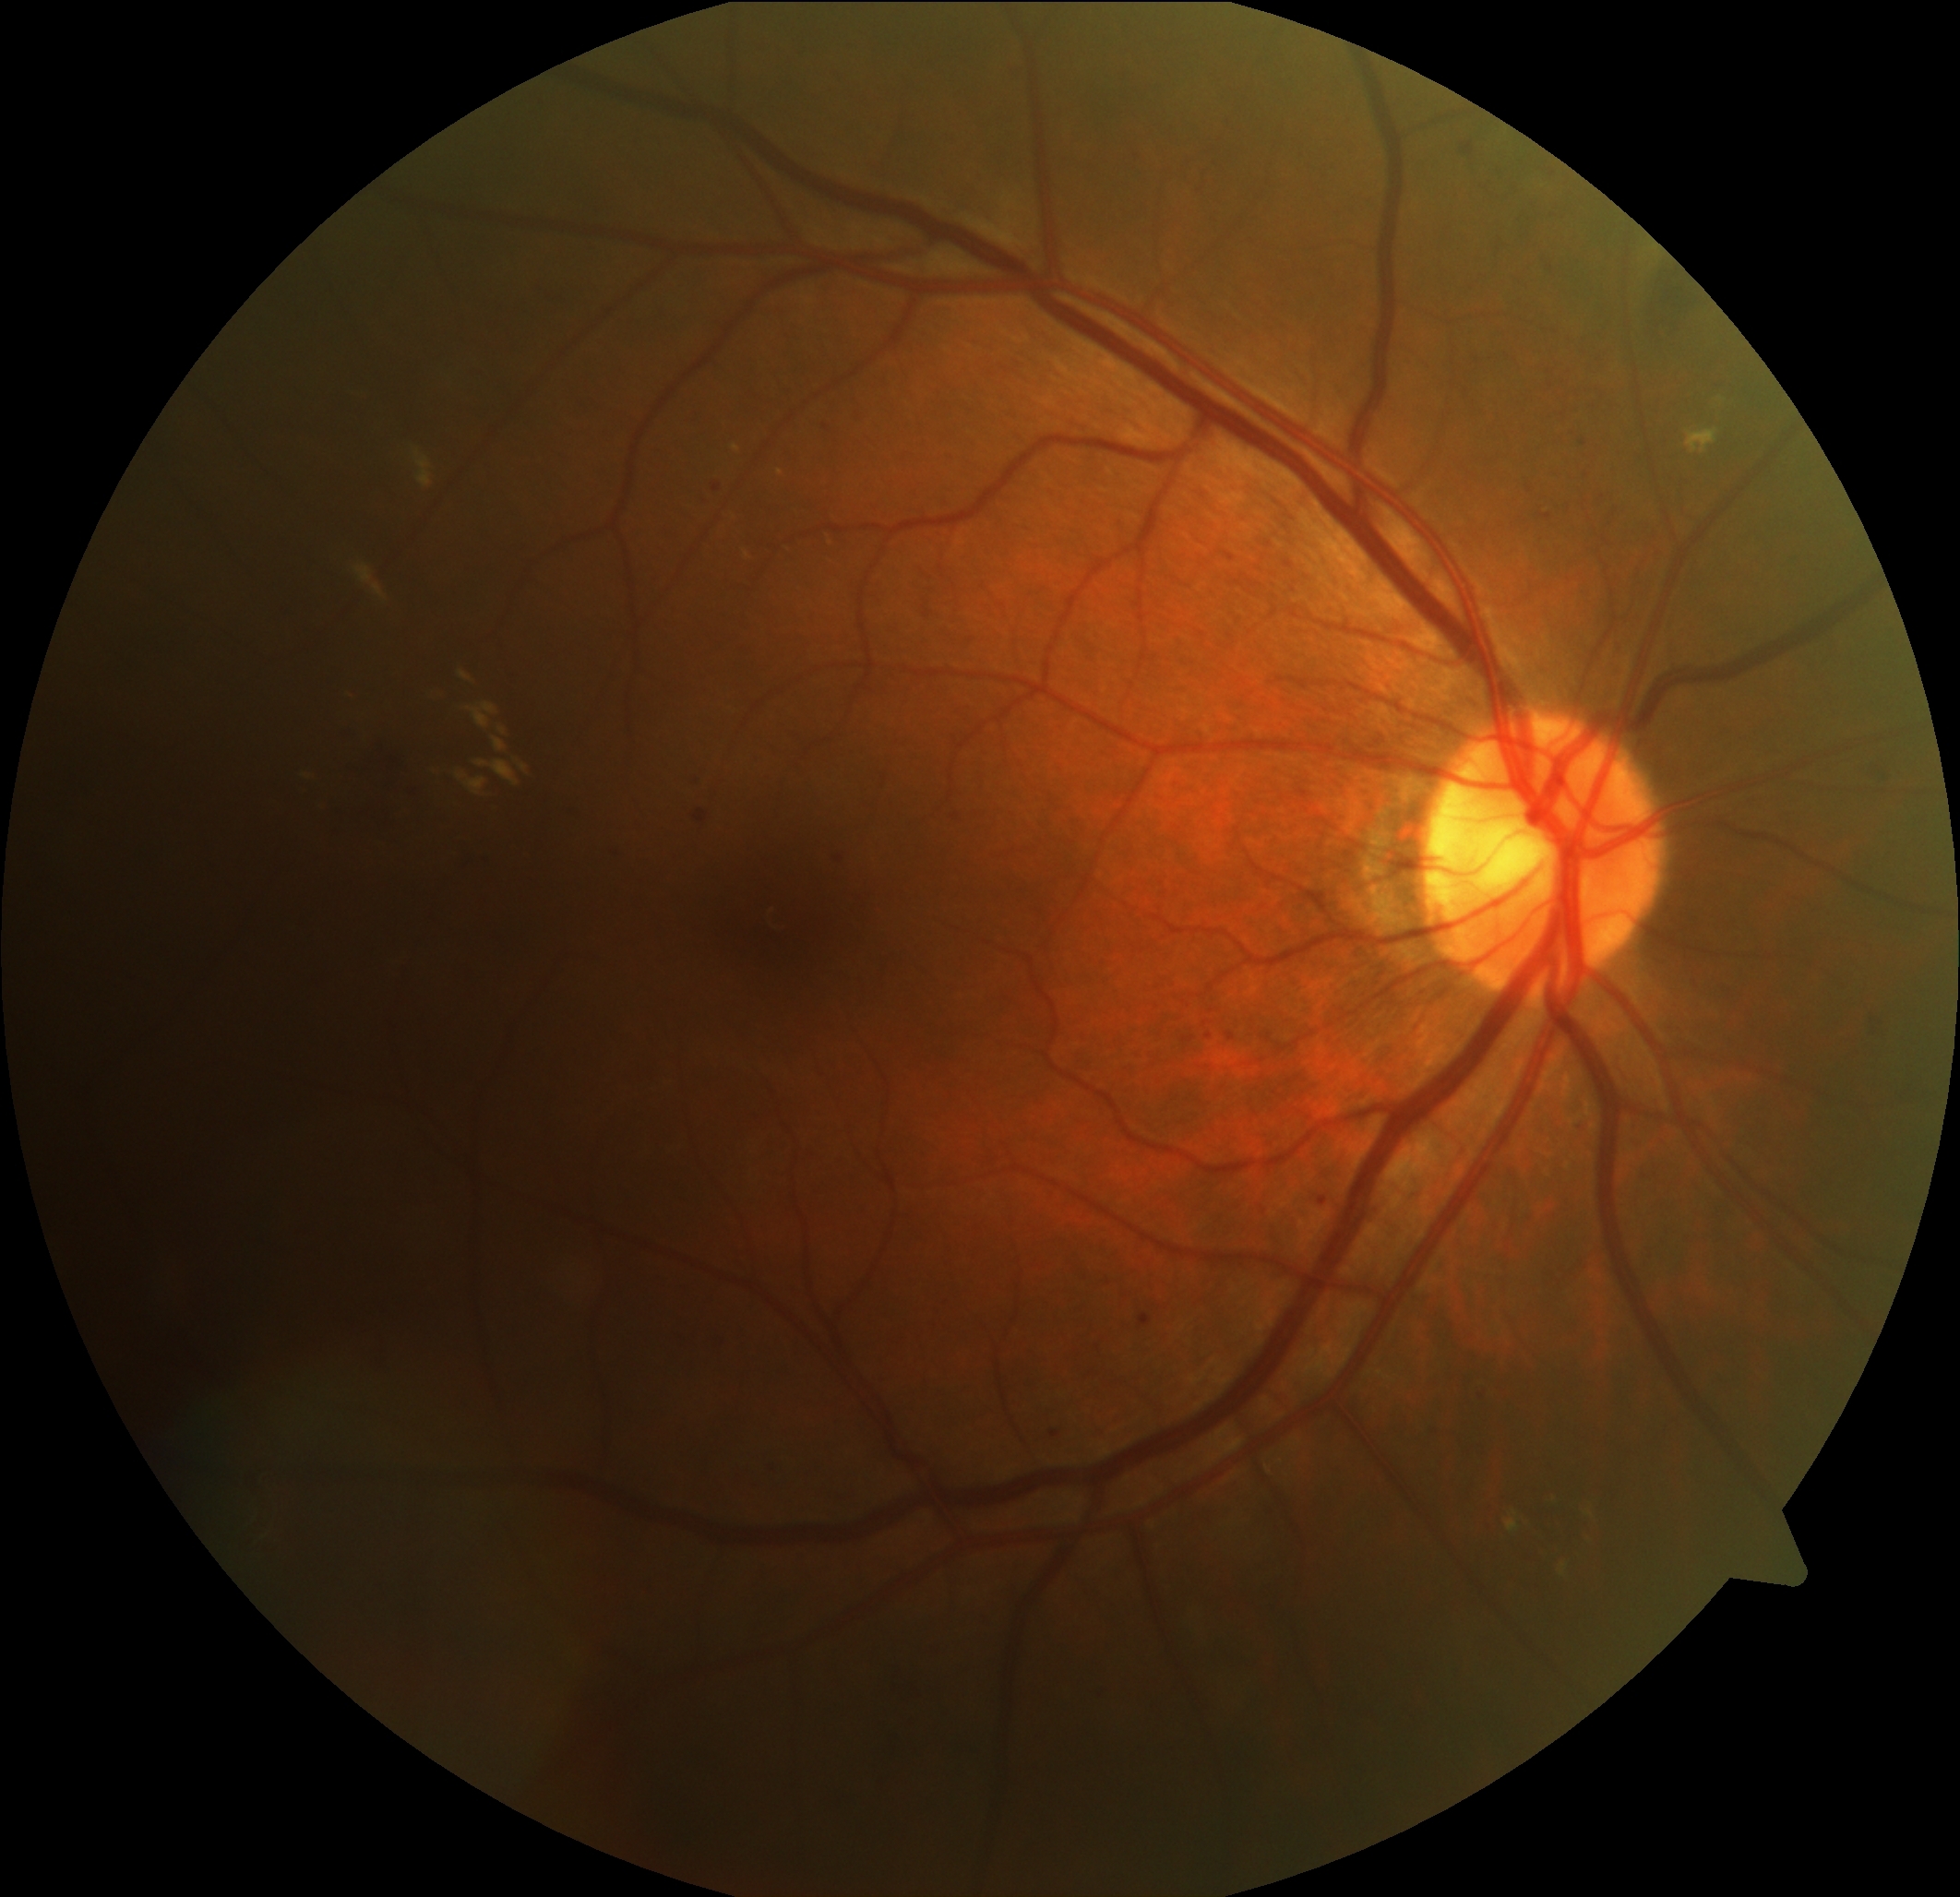 DR severity: moderate NPDR (grade 2).